240 x 240 pixels · non-mydriatic fundus camera · optic disc-centered crop — 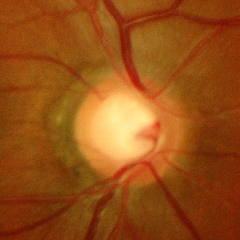

There is evidence of advanced glaucoma. Diagnostic criteria: near-total cupping of the optic nerve head, with or without severe visual field loss within the central 10 degrees of fixation.